2048 x 1536 pixels.
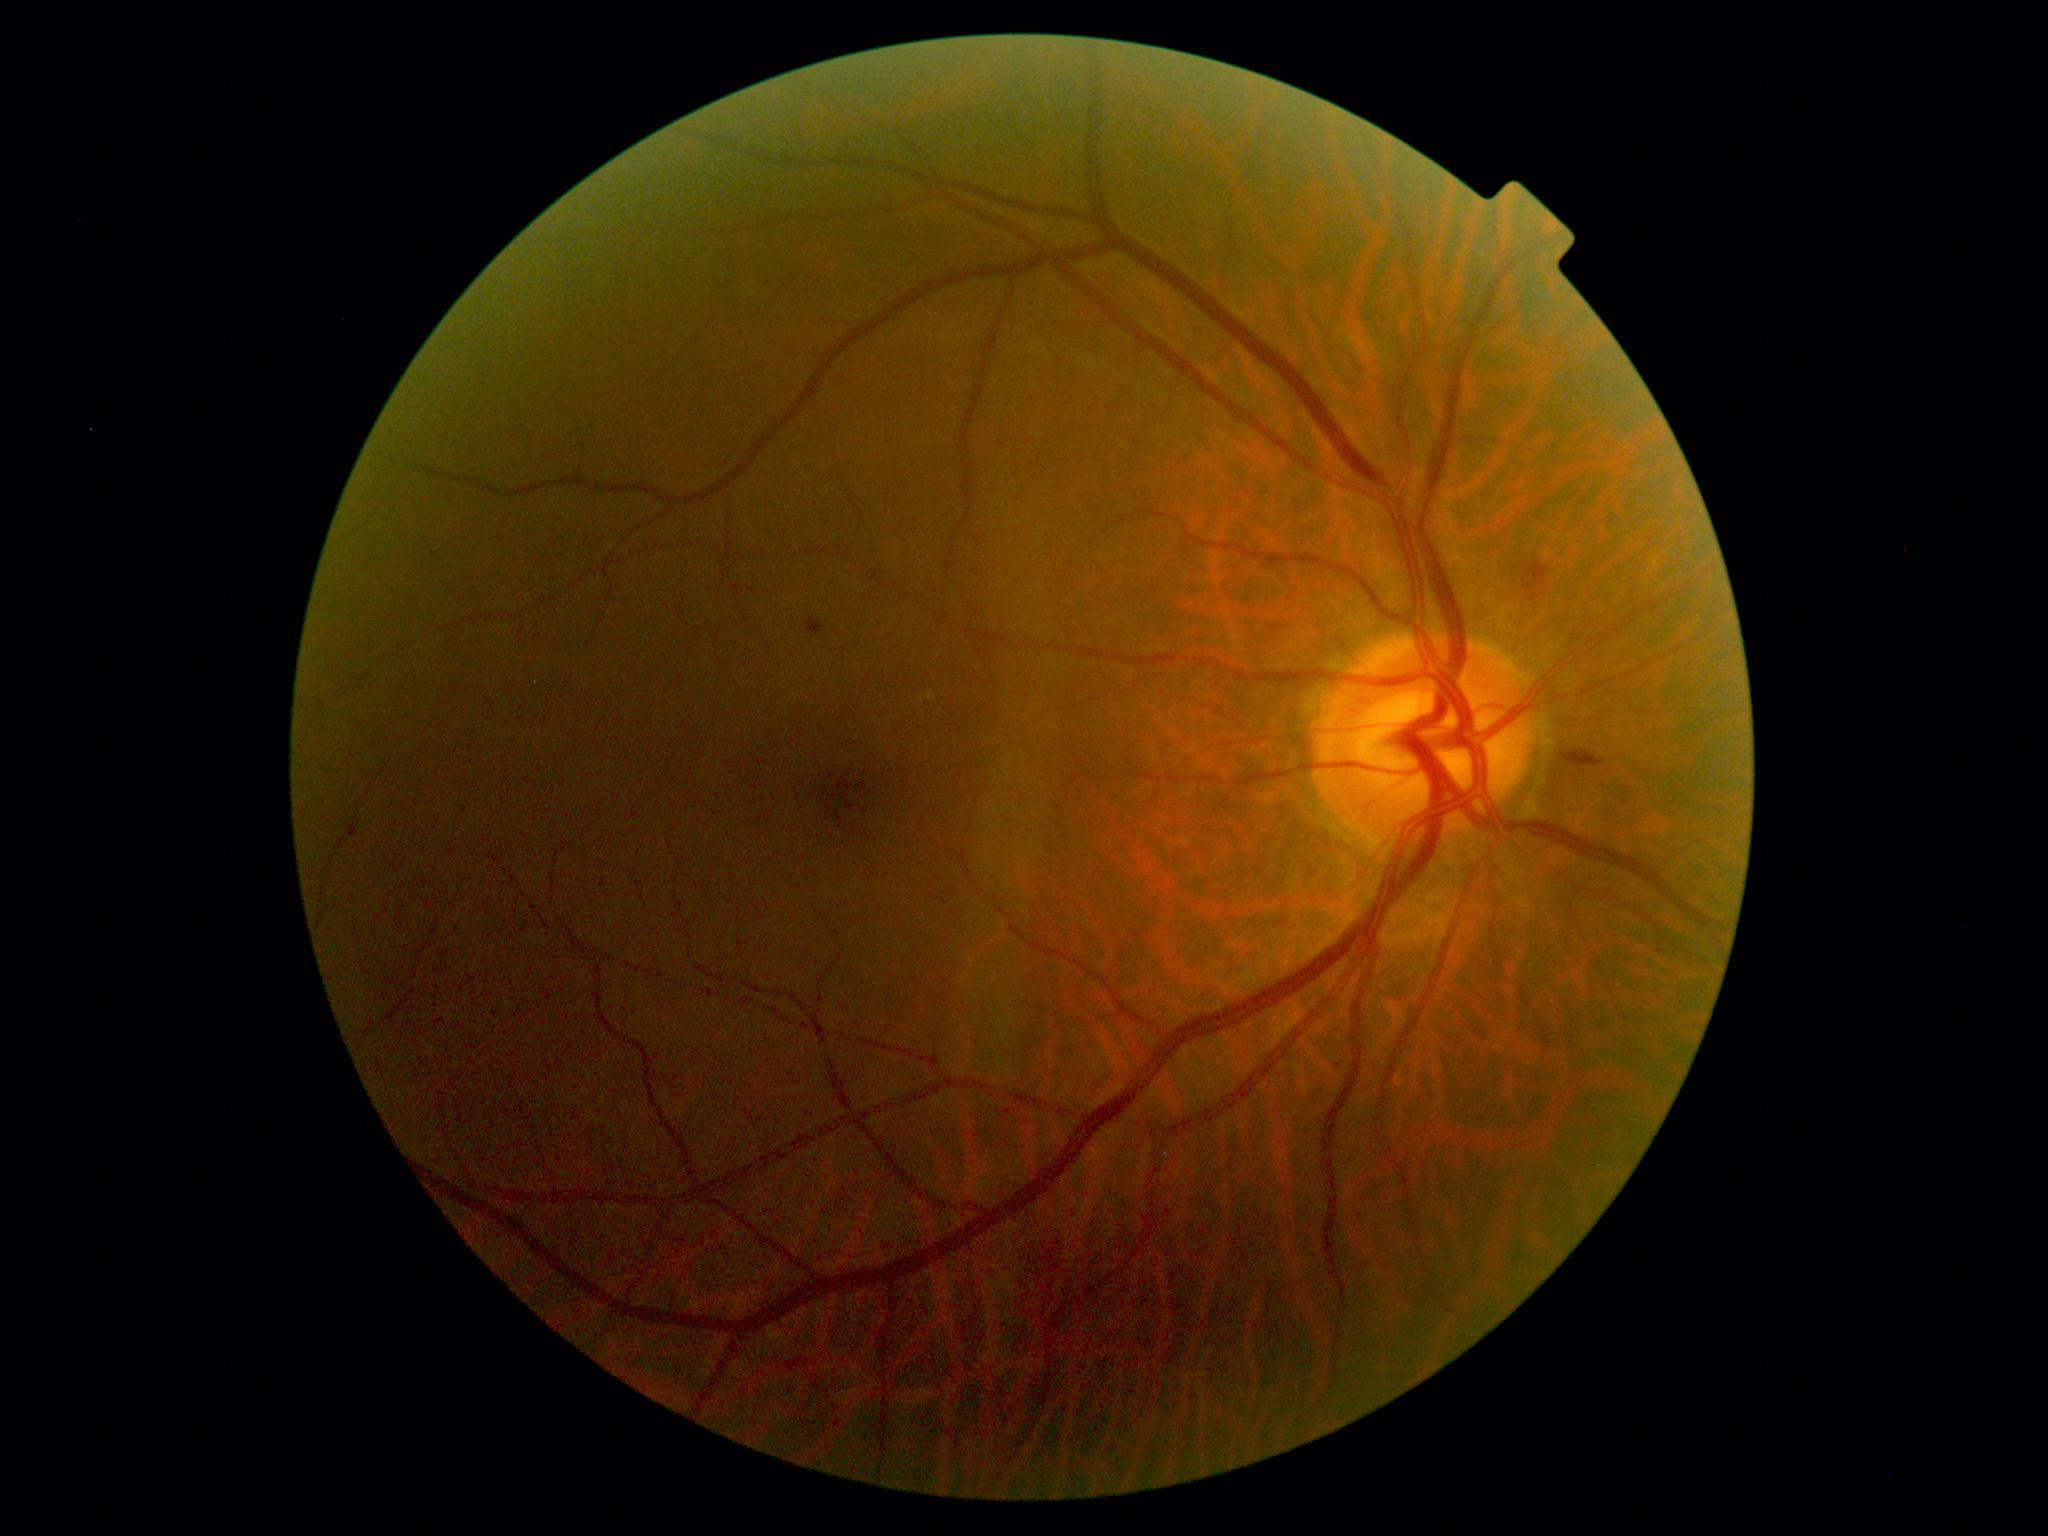
* retinopathy — grade 2